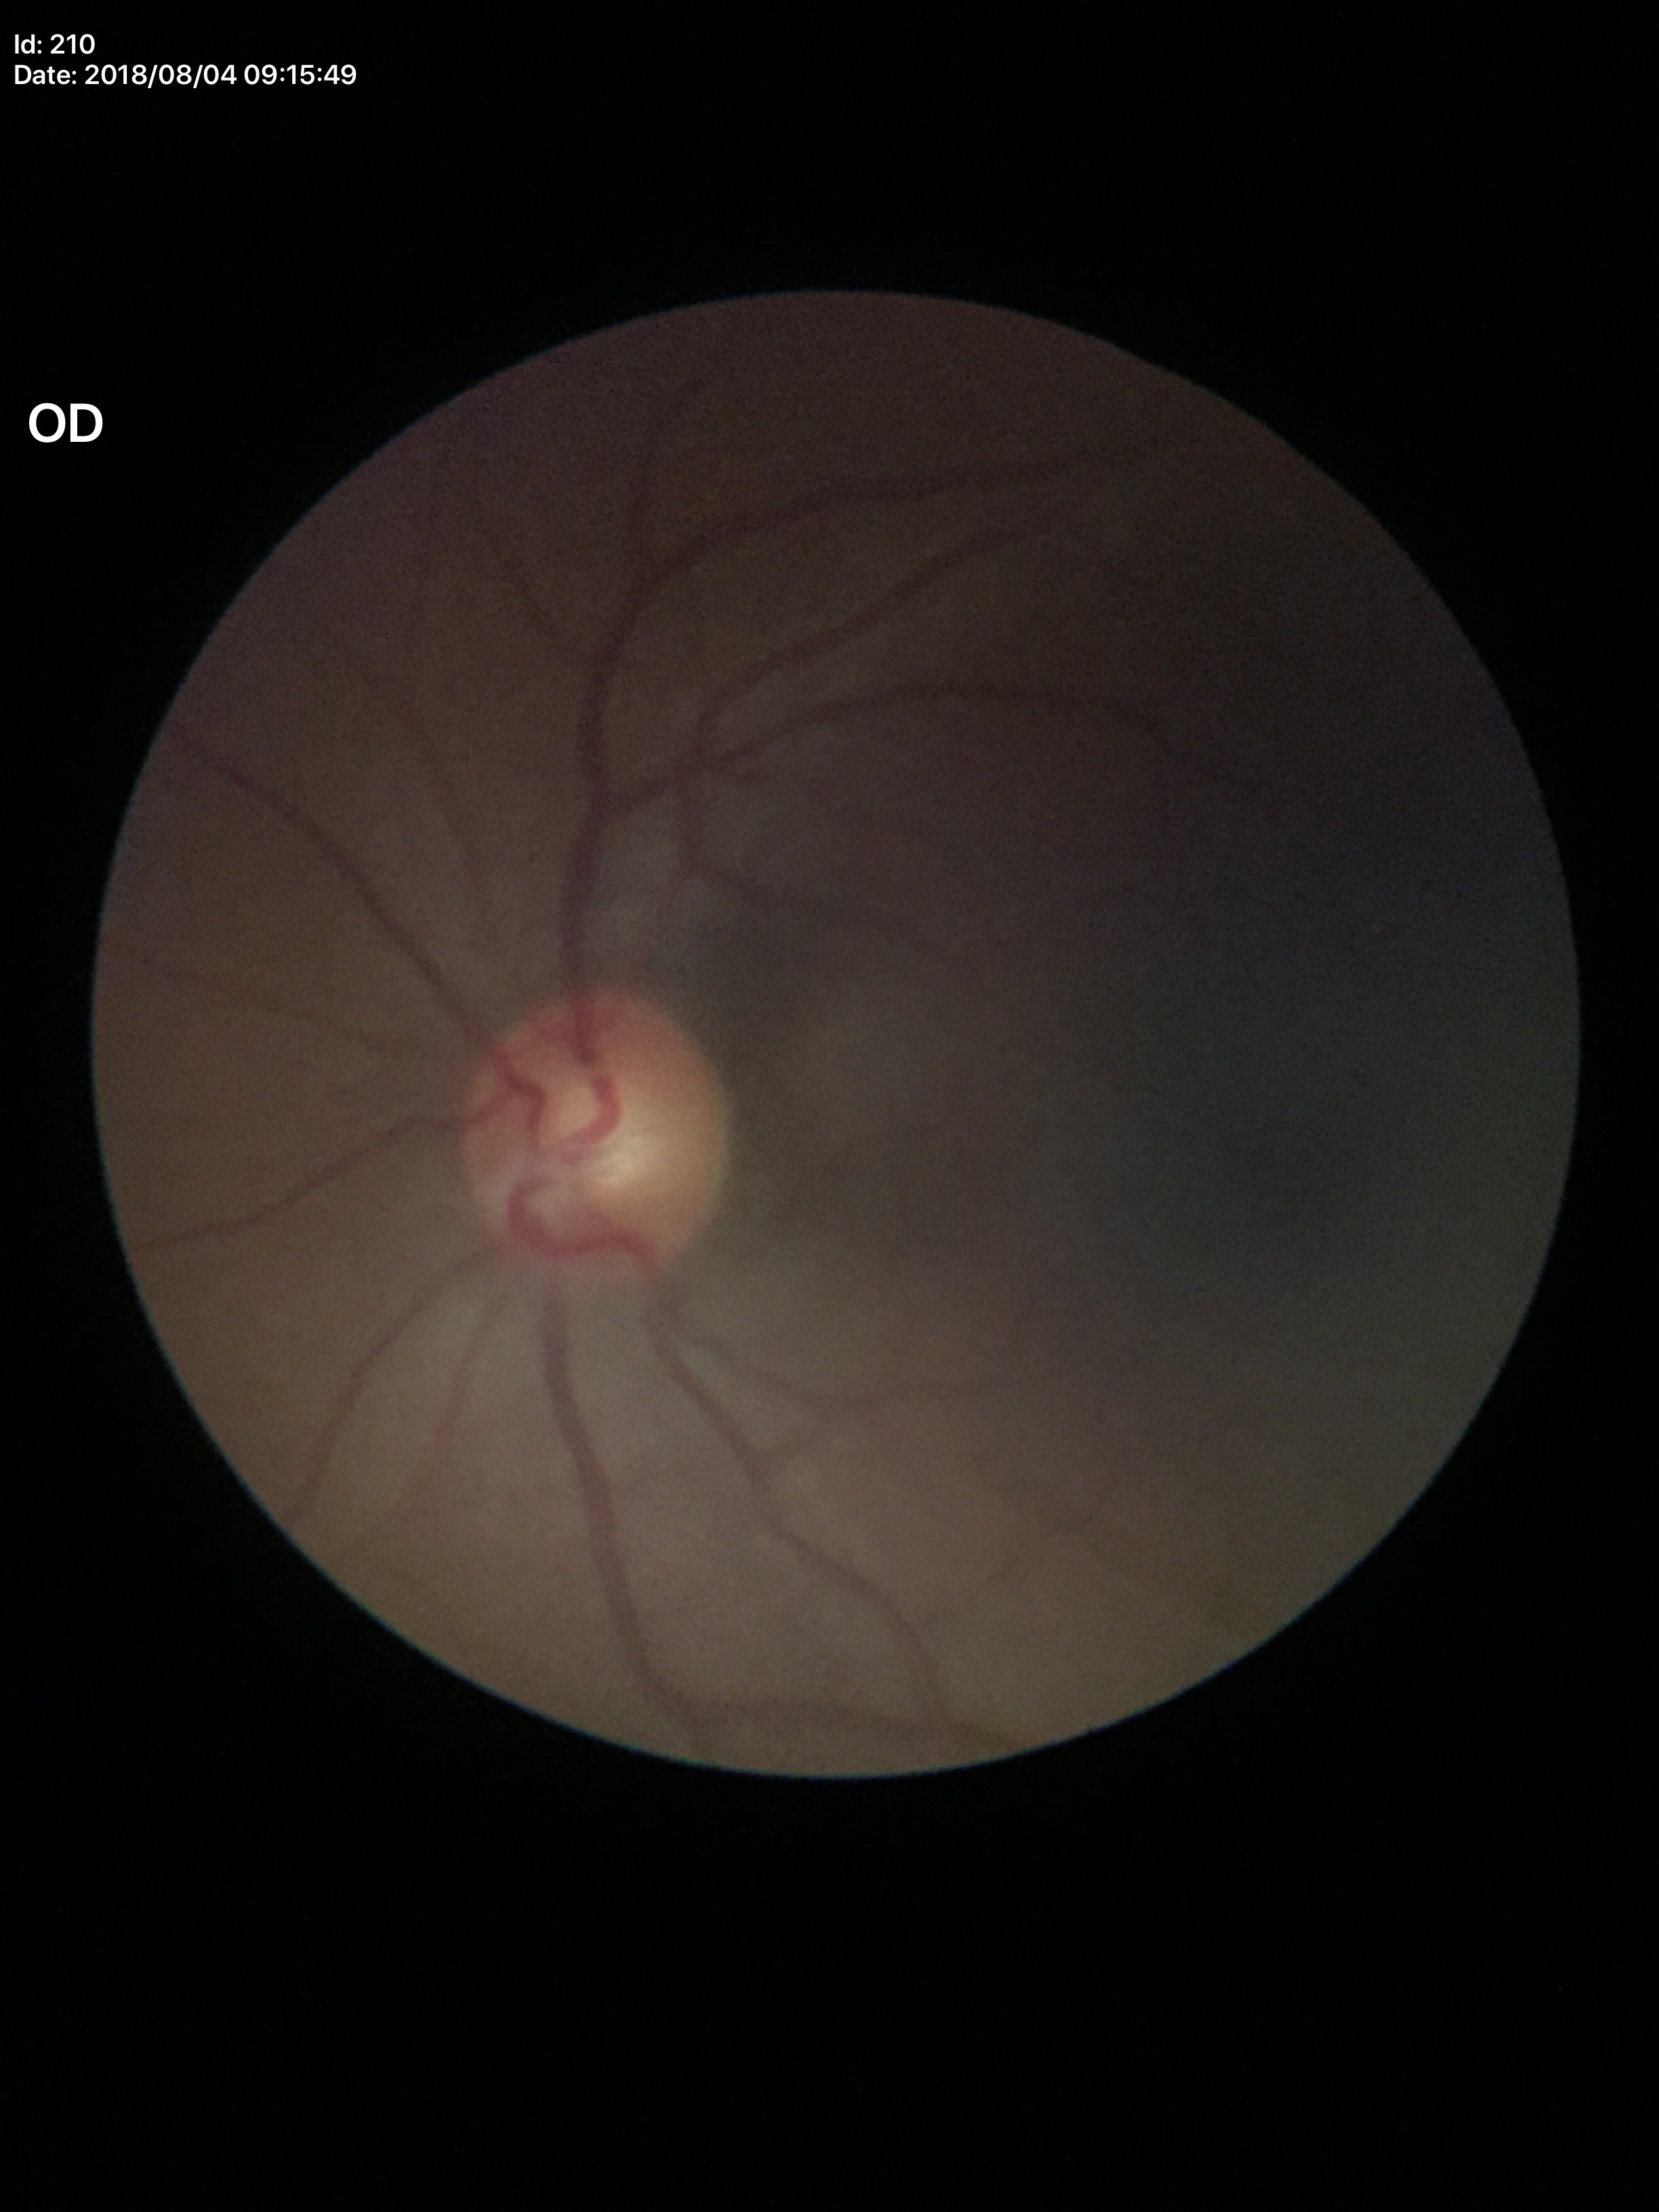
glaucoma_decision: negative (5/5 ophthalmologists in agreement)
vcdr: 0.53